Retinal fundus photograph — 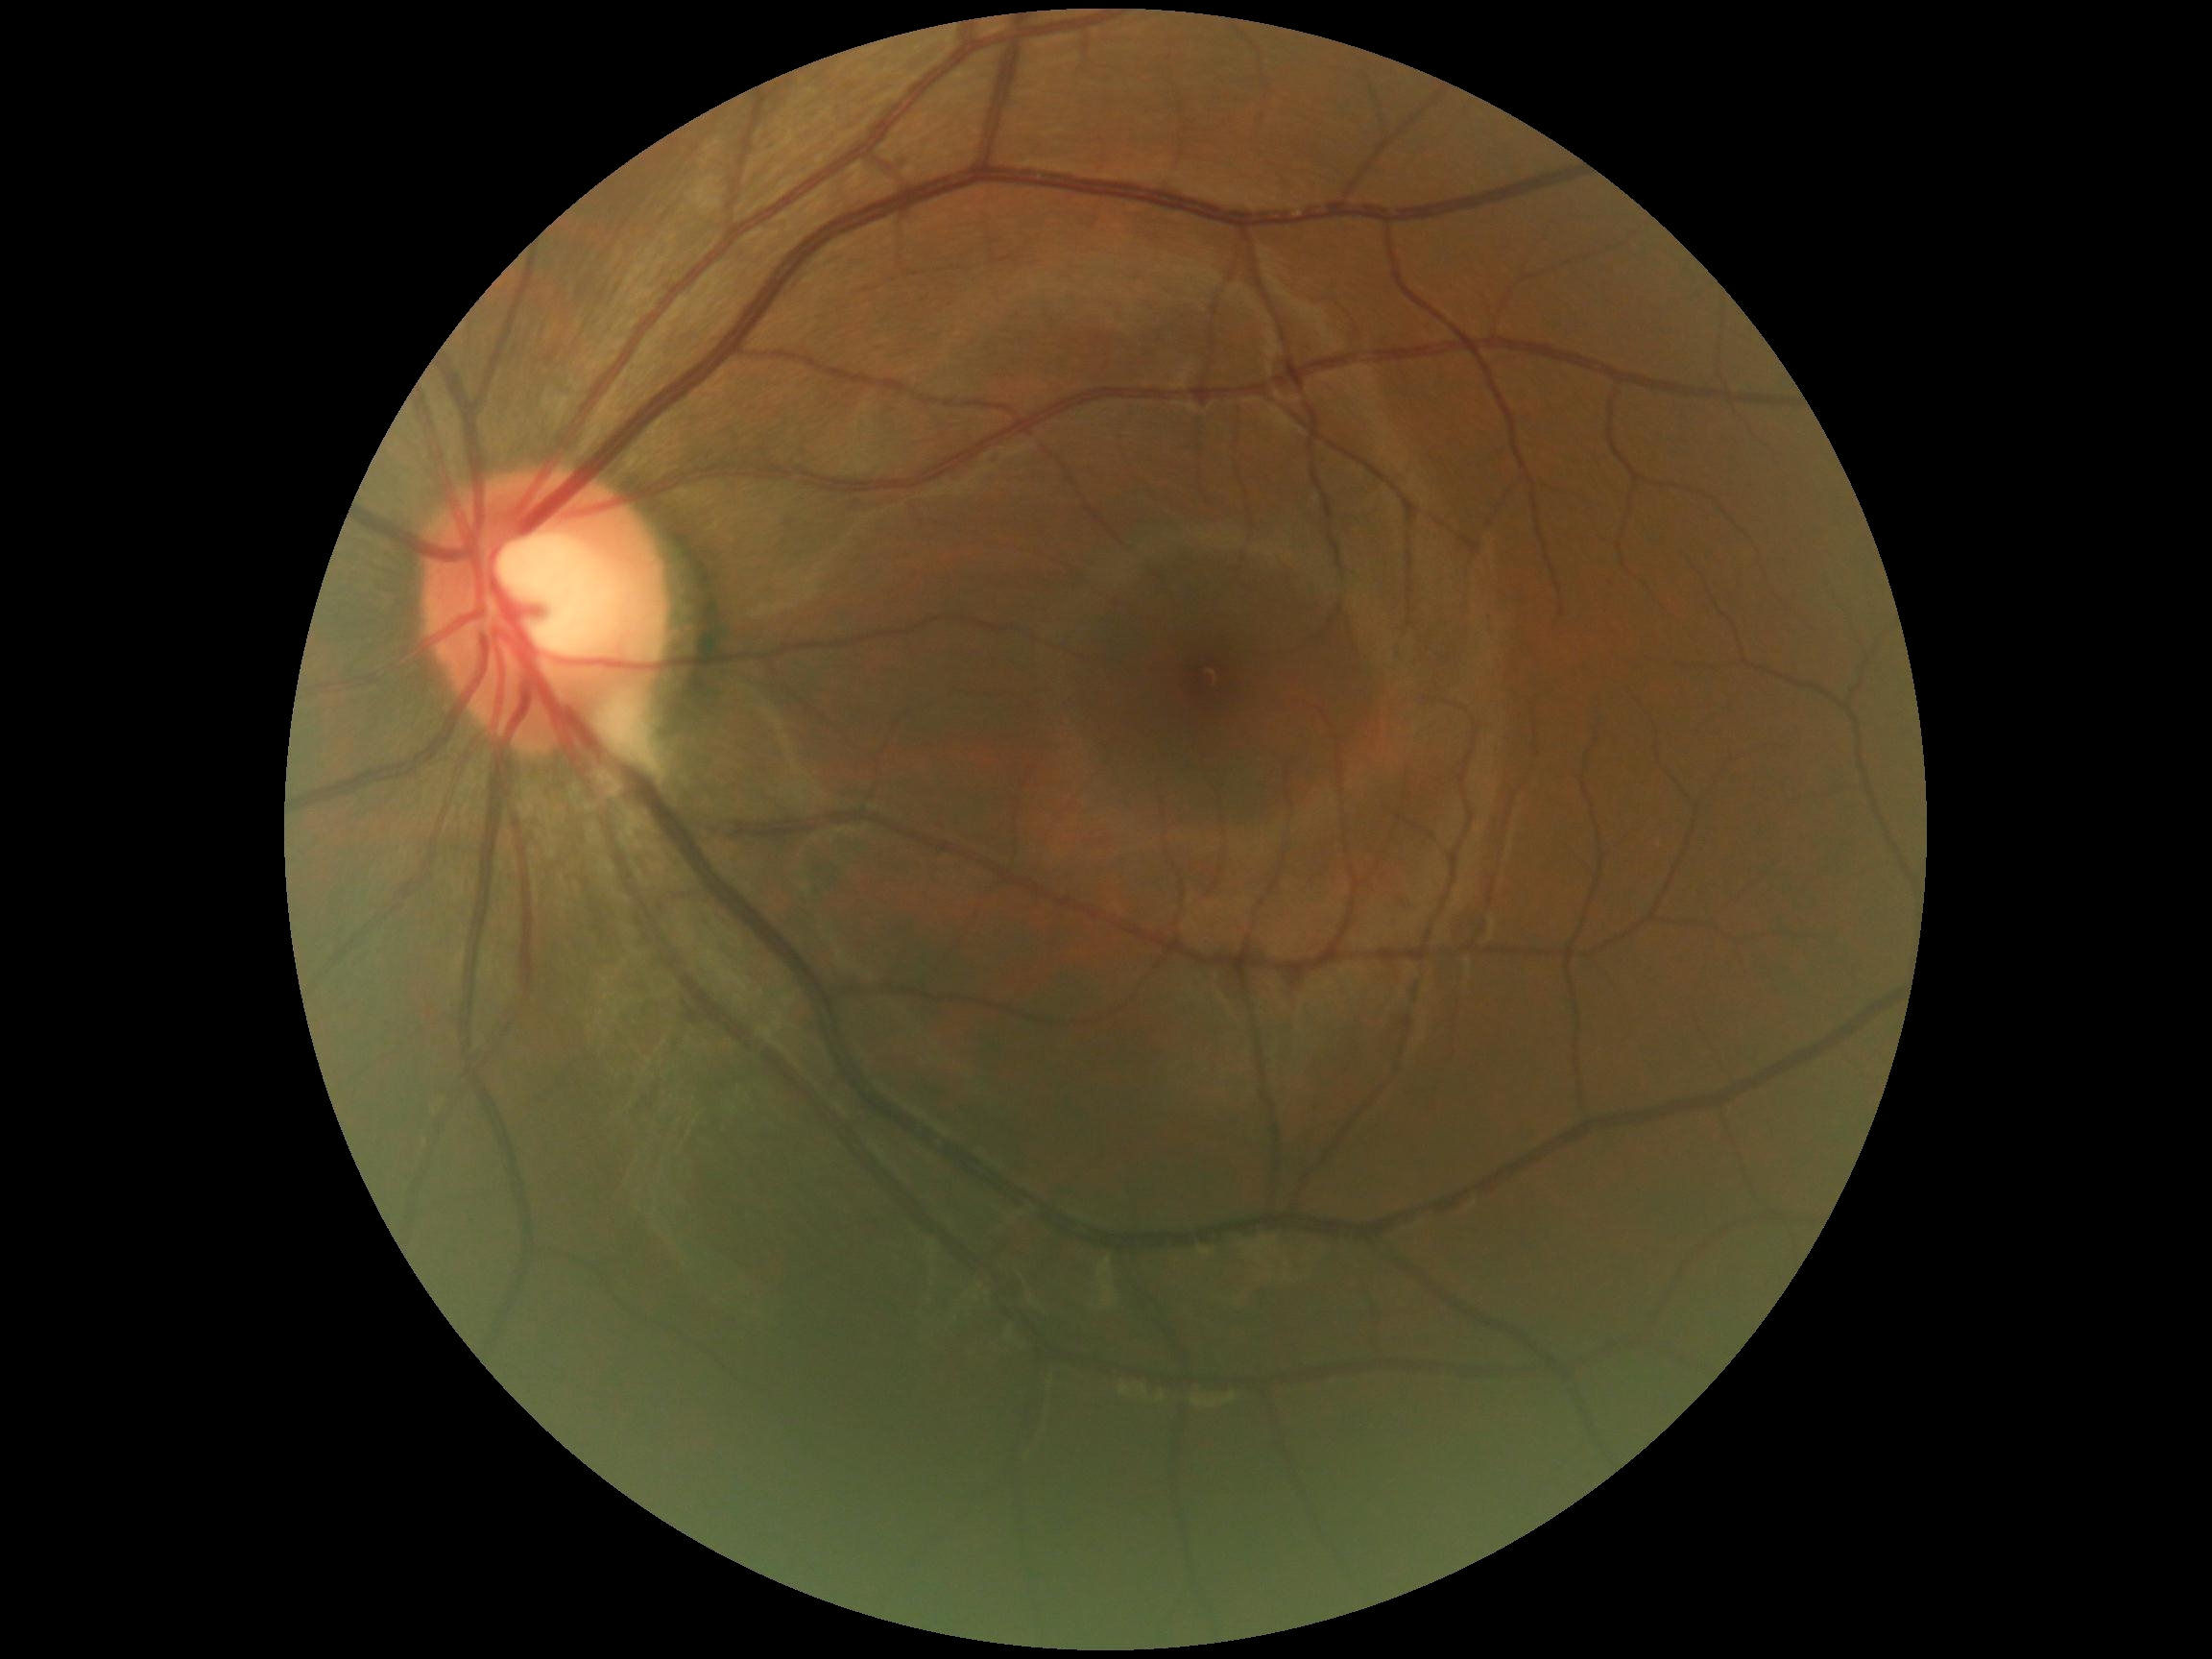
Diabetic retinopathy (DR) is grade 0 — no visible signs of diabetic retinopathy.